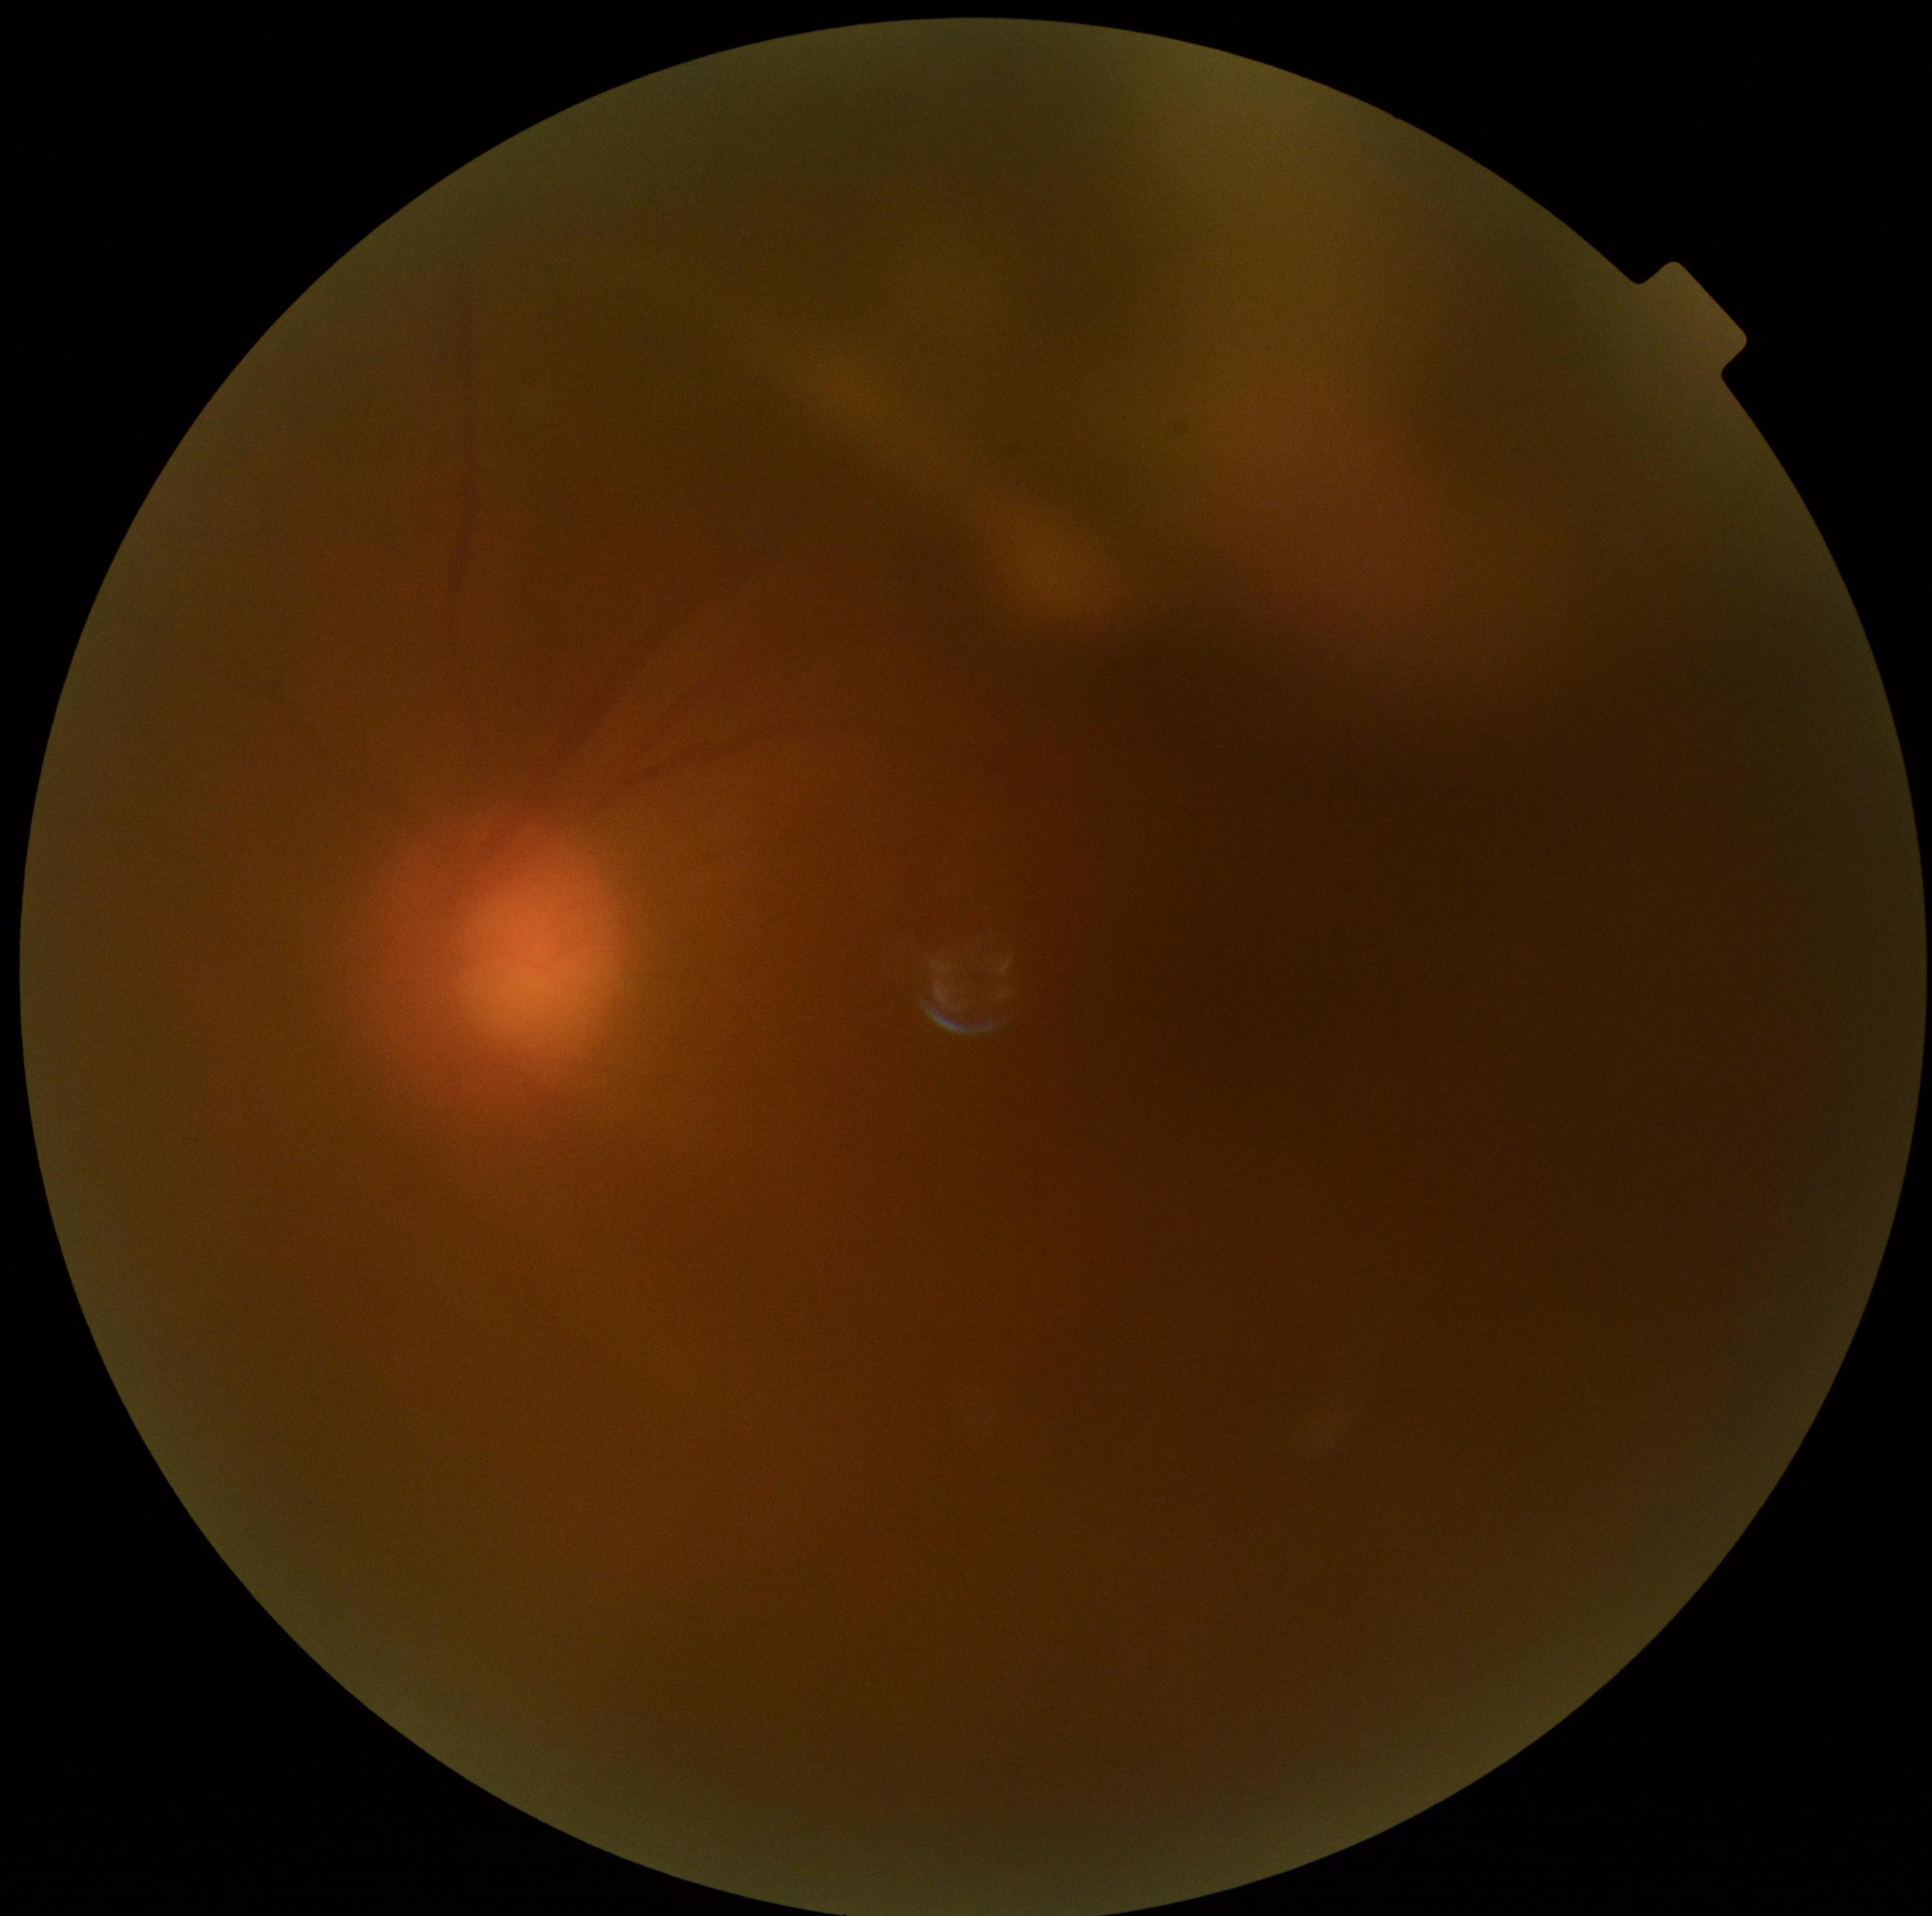

{
  "dr_grade": "ungradable due to poor image quality"
}